Retinal fundus photograph:
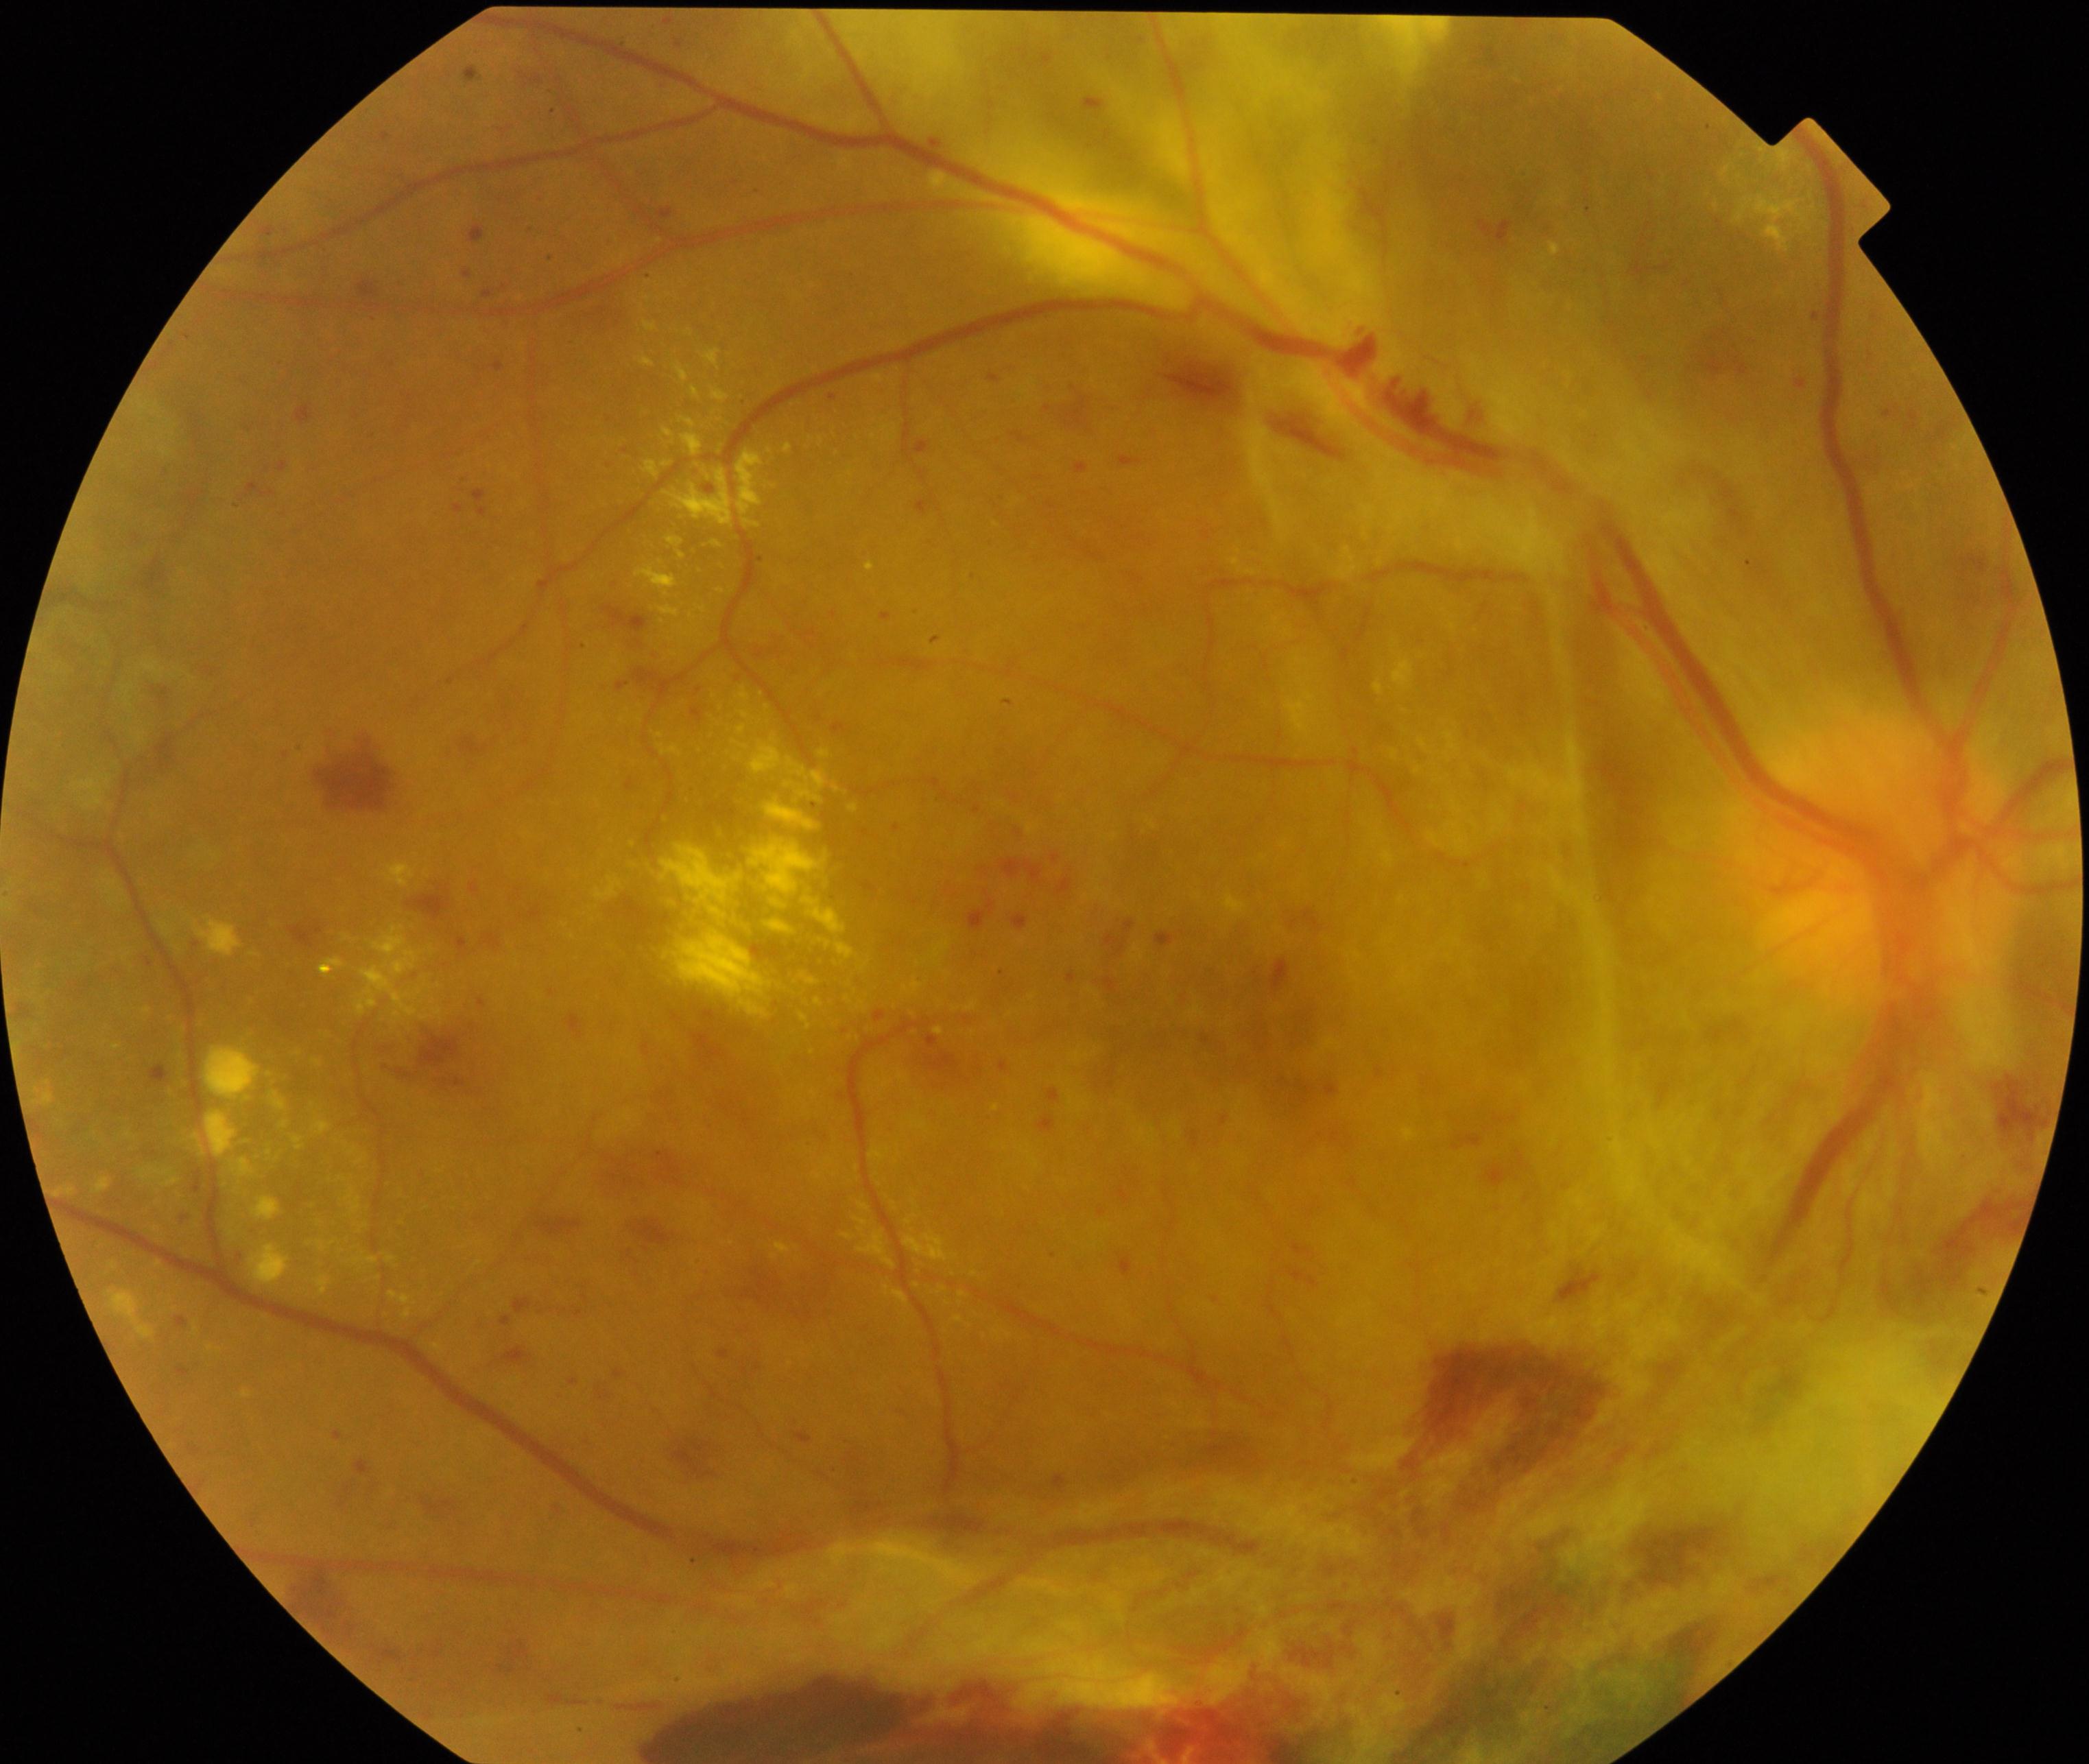
Impression: severe non-proliferative or proliferative diabetic retinopathy.